Wide-field fundus image from infant ROP screening; Natus RetCam Envision, 130° FOV: 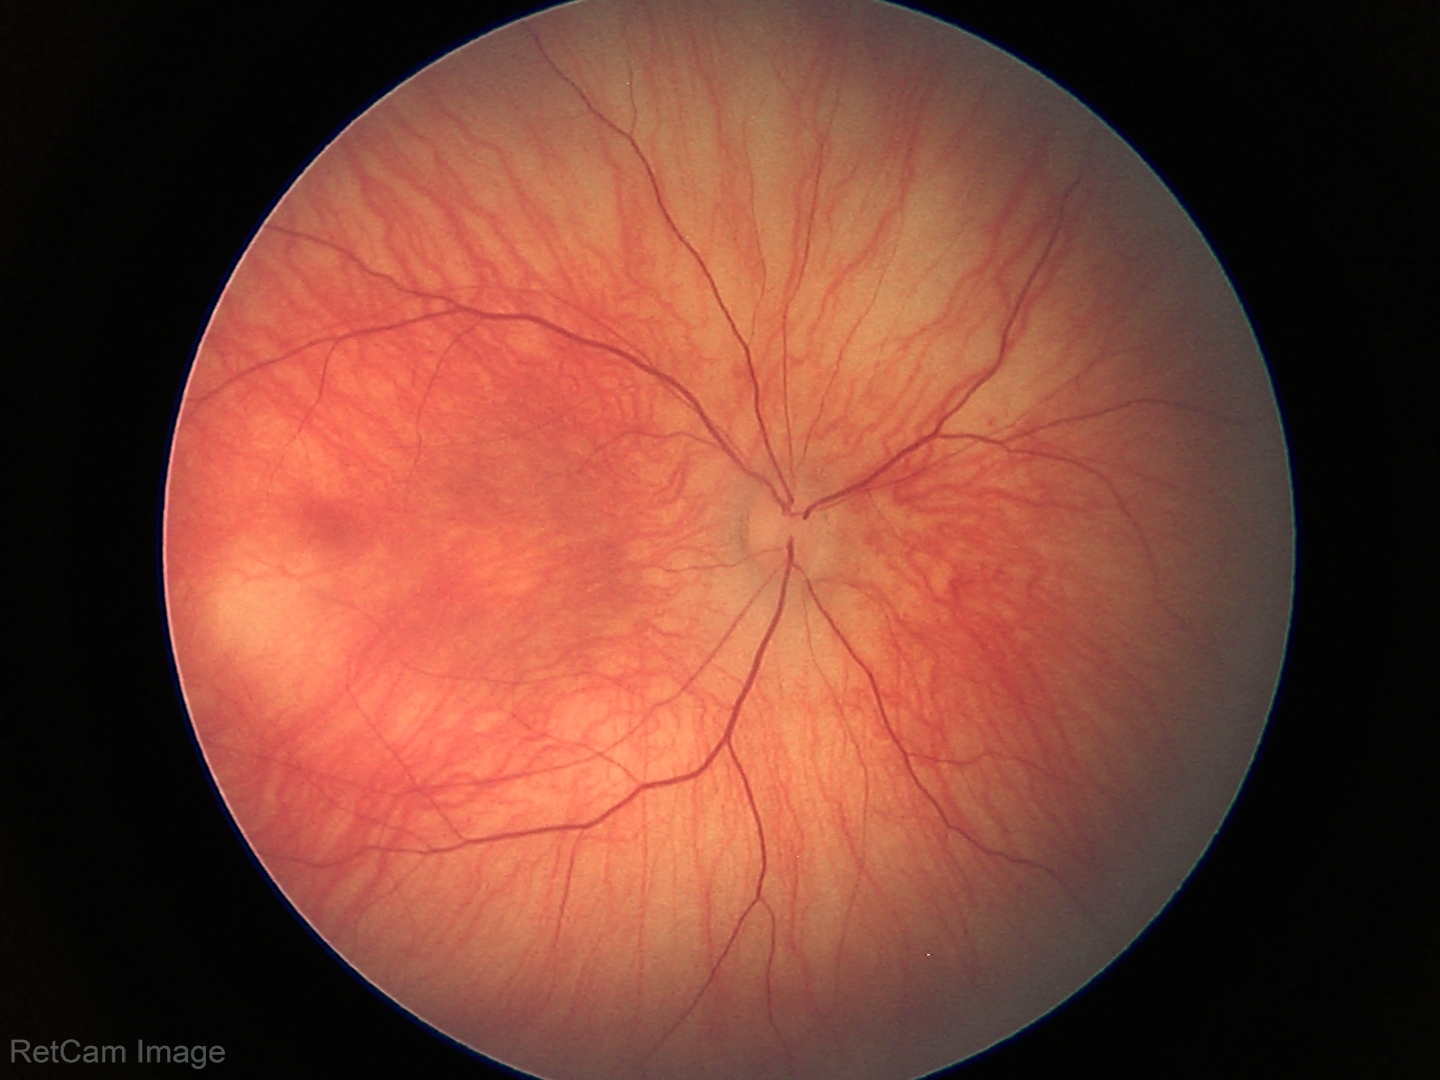
Finding = normal.